Modified Davis grading — 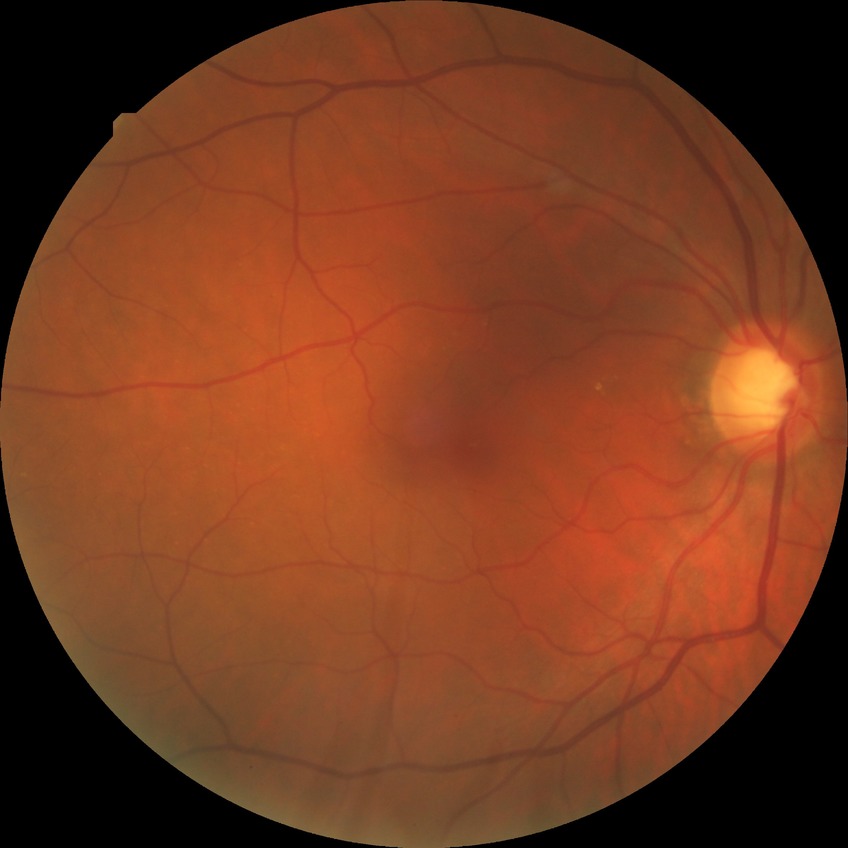

Modified Davis classification is no diabetic retinopathy.